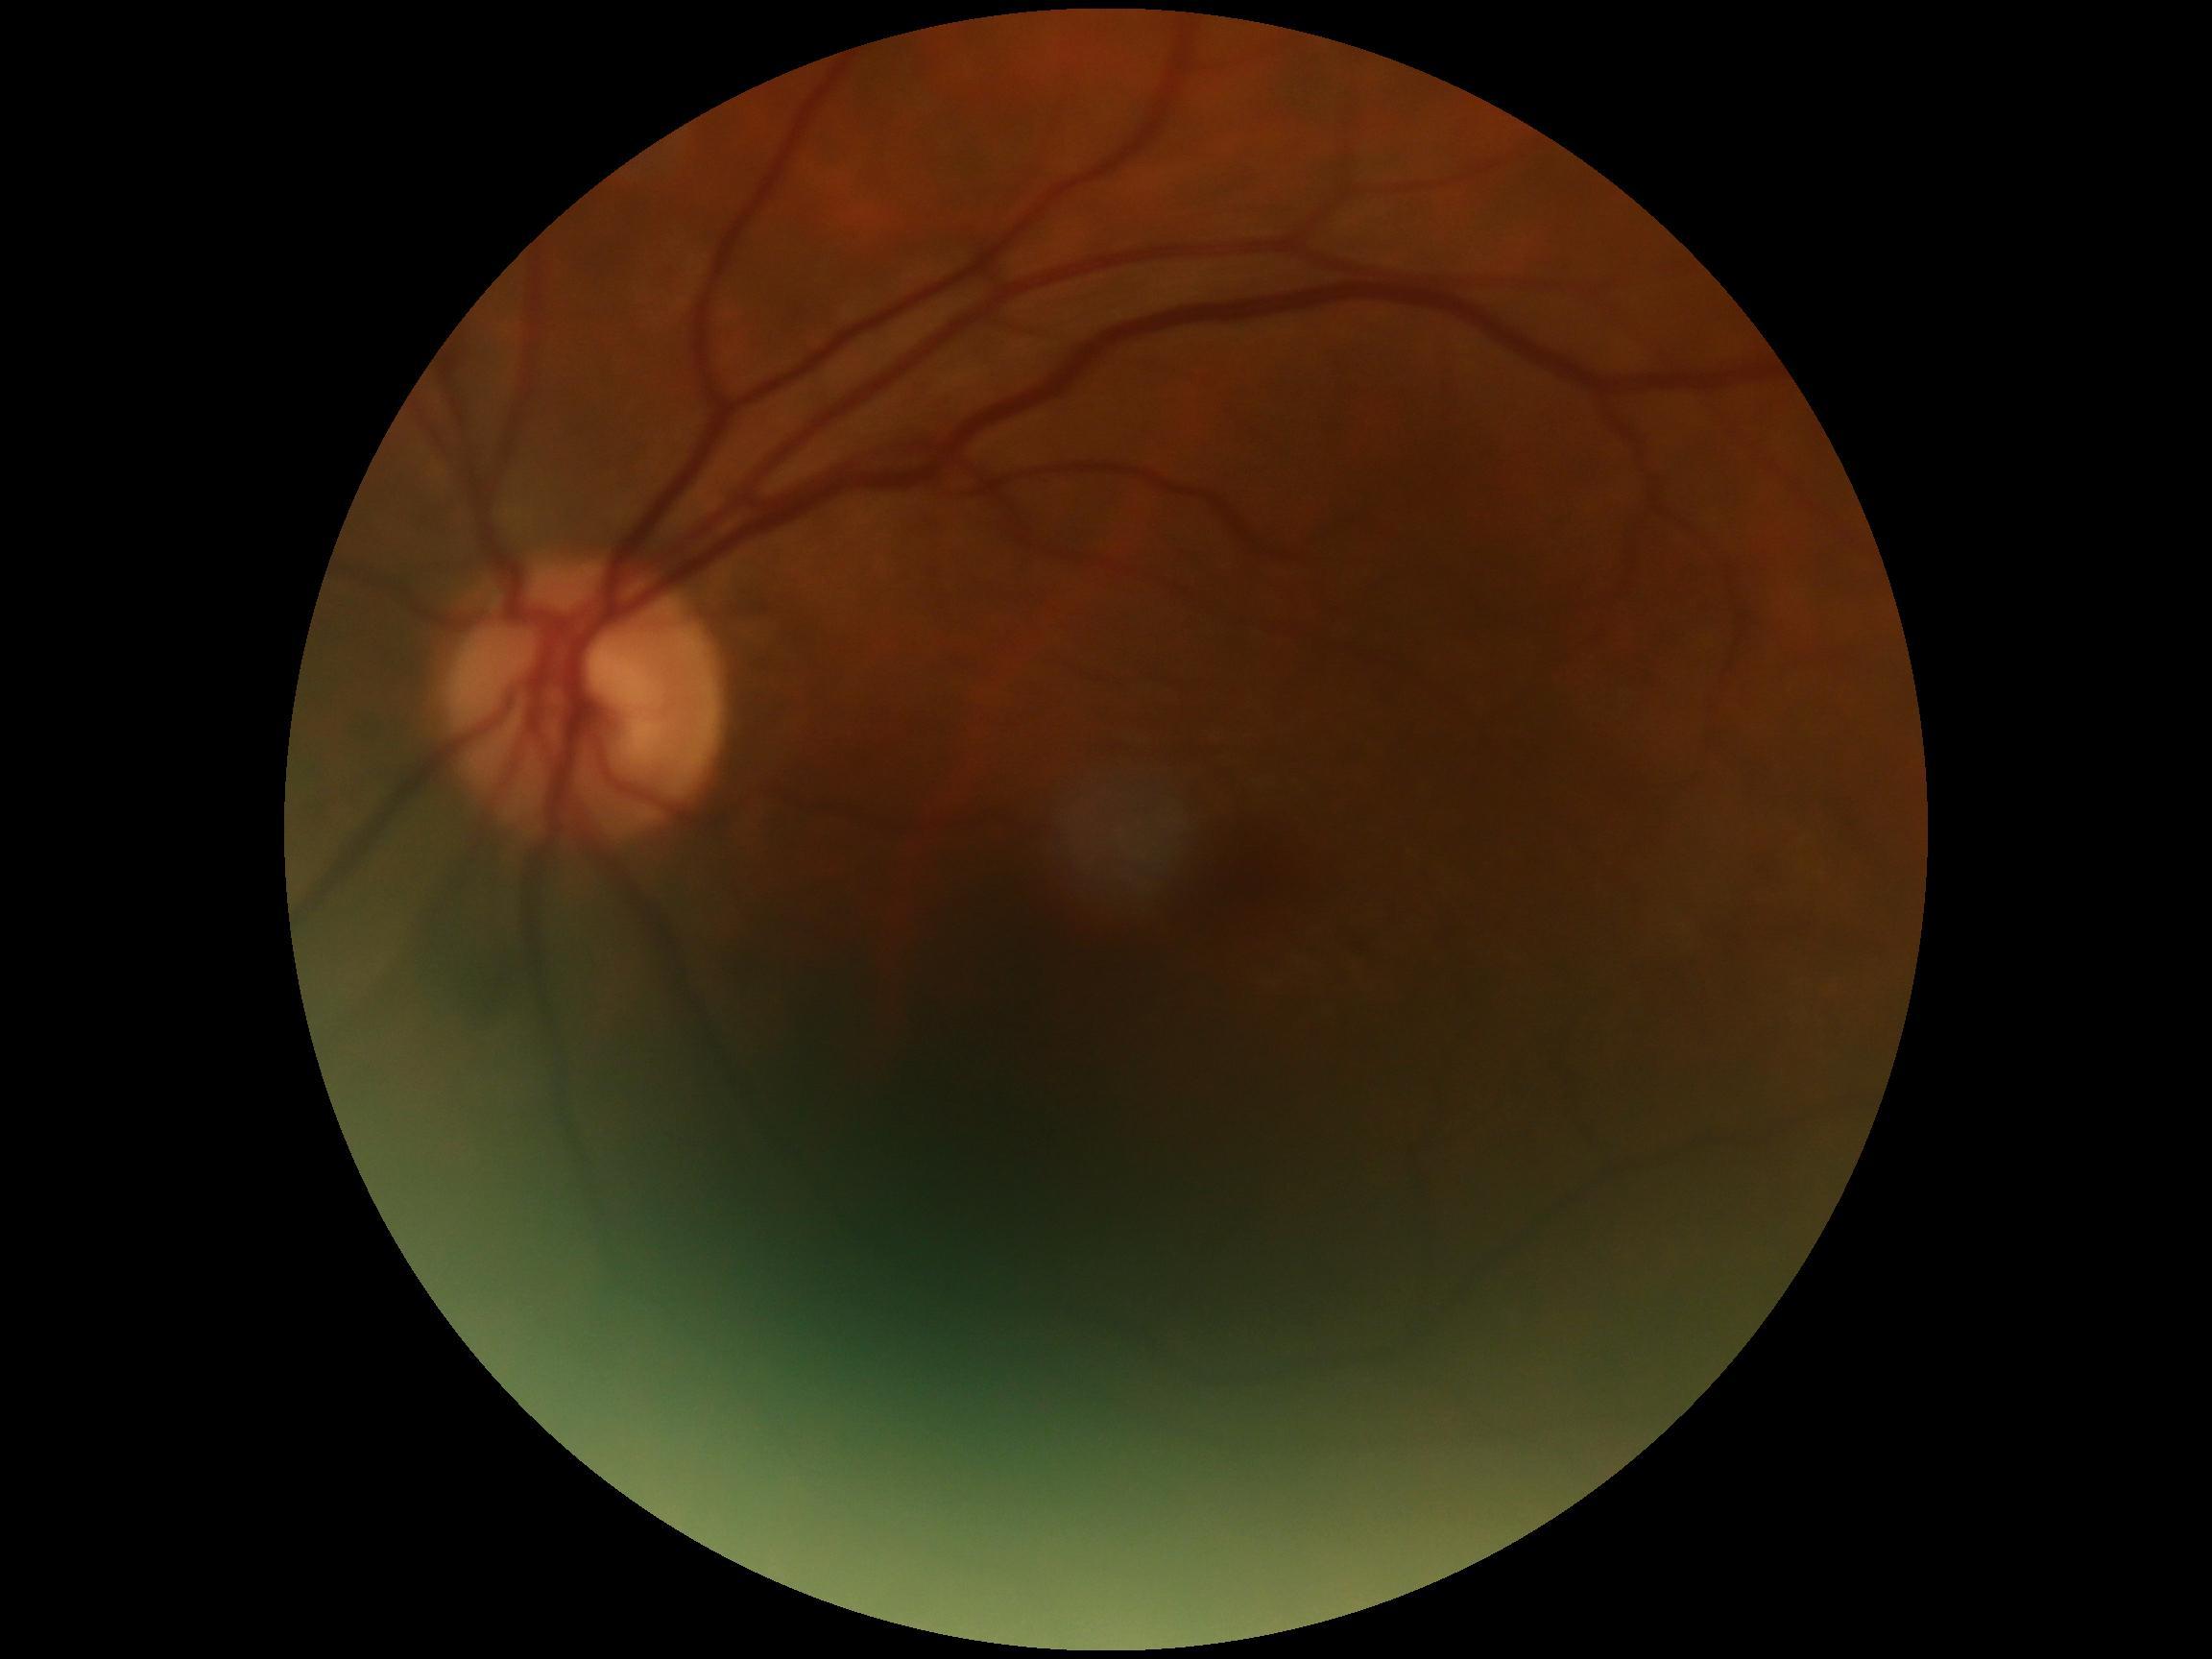
DR grade is 0/4.